848x848px · without pupil dilation · CFP · DR severity per modified Davis staging.
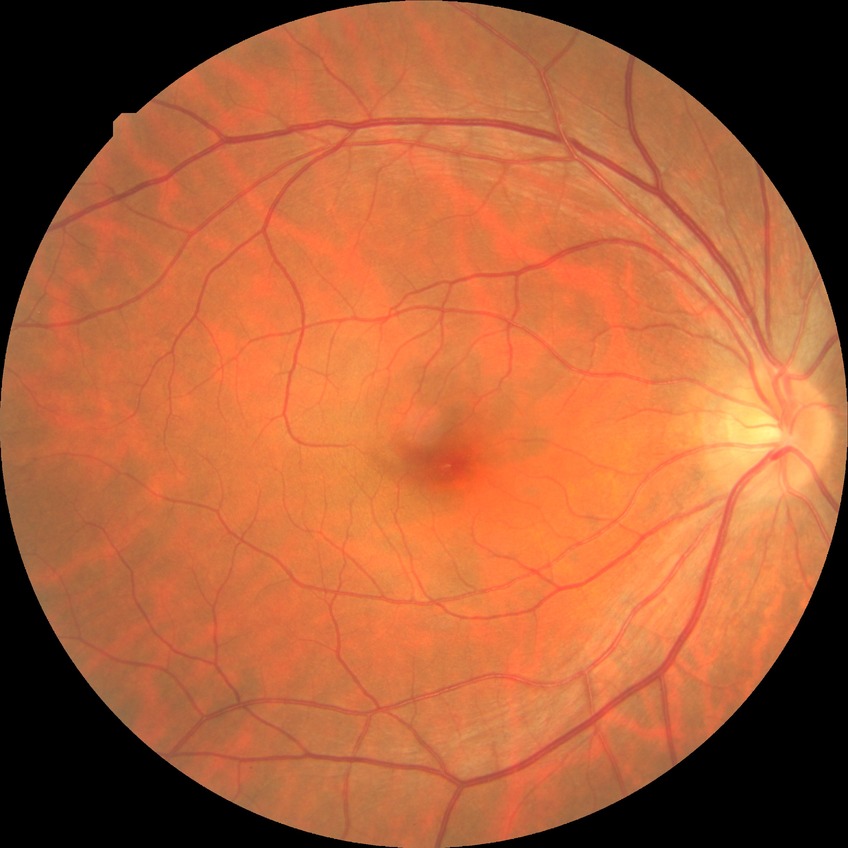 Diabetic retinopathy severity is no diabetic retinopathy.